45-degree field of view.
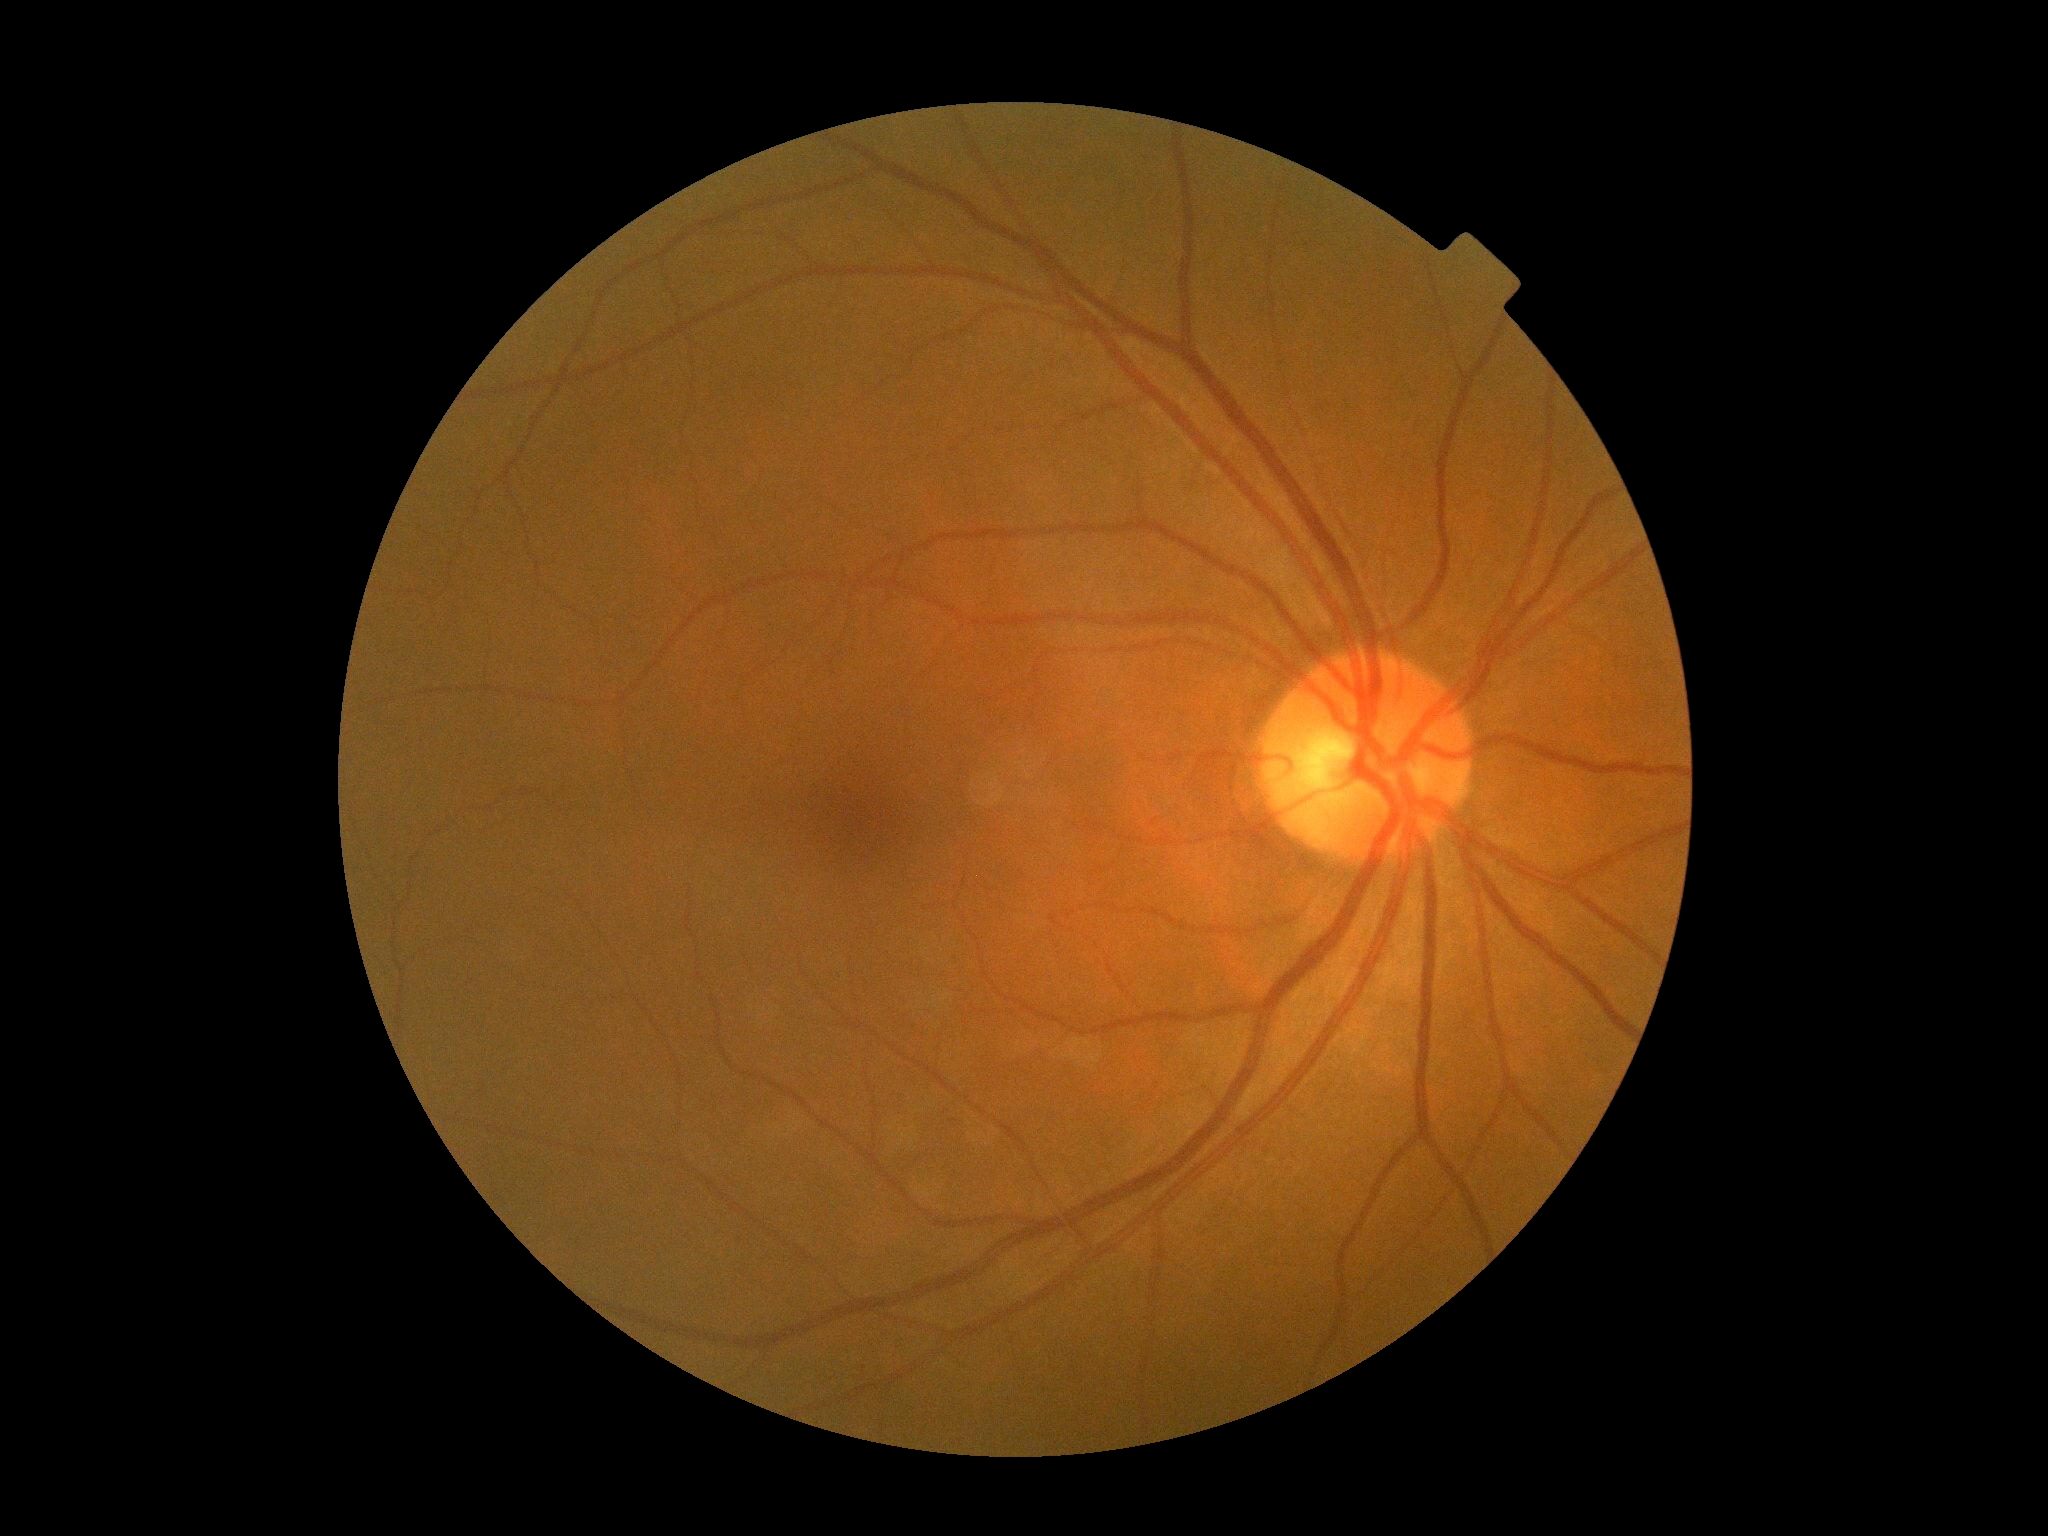
No signs of diabetic retinopathy.
Diabetic retinopathy grade: 0 (no apparent retinopathy).